2352x1568px; 45° field of view; color fundus photograph: 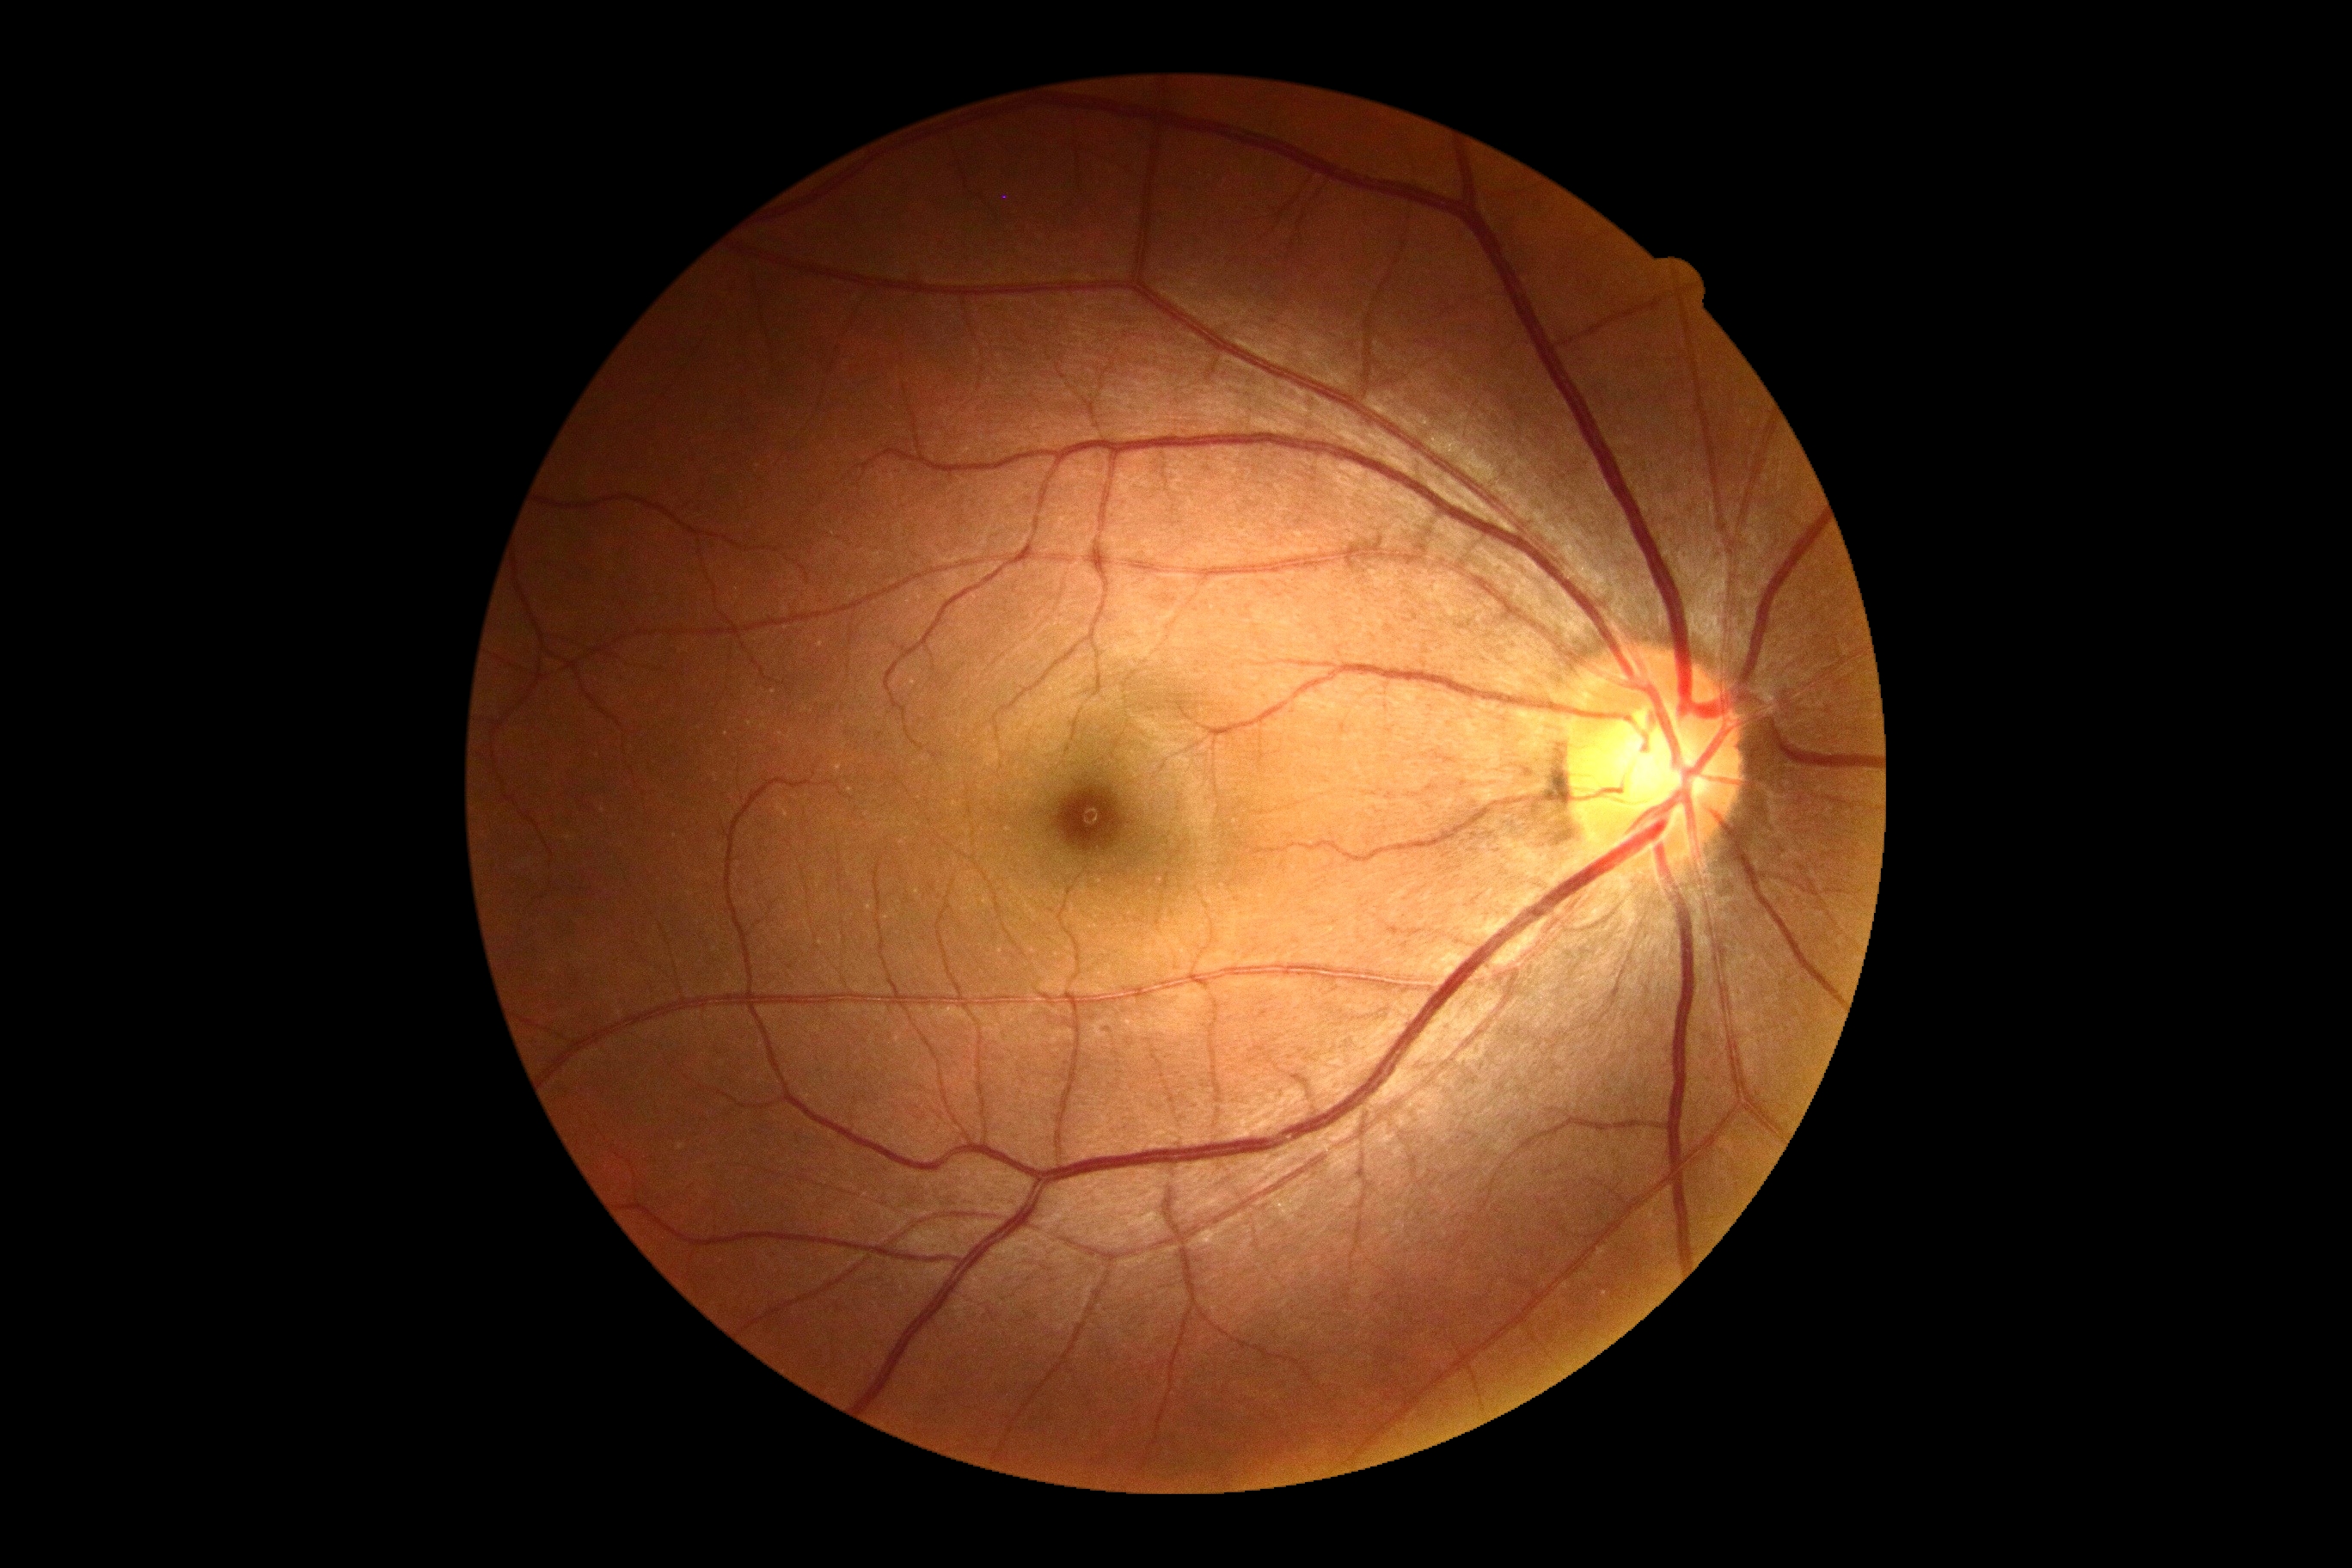 Findings:
• DR grade — no apparent retinopathy (0)